Posterior pole view · 2228x1652:
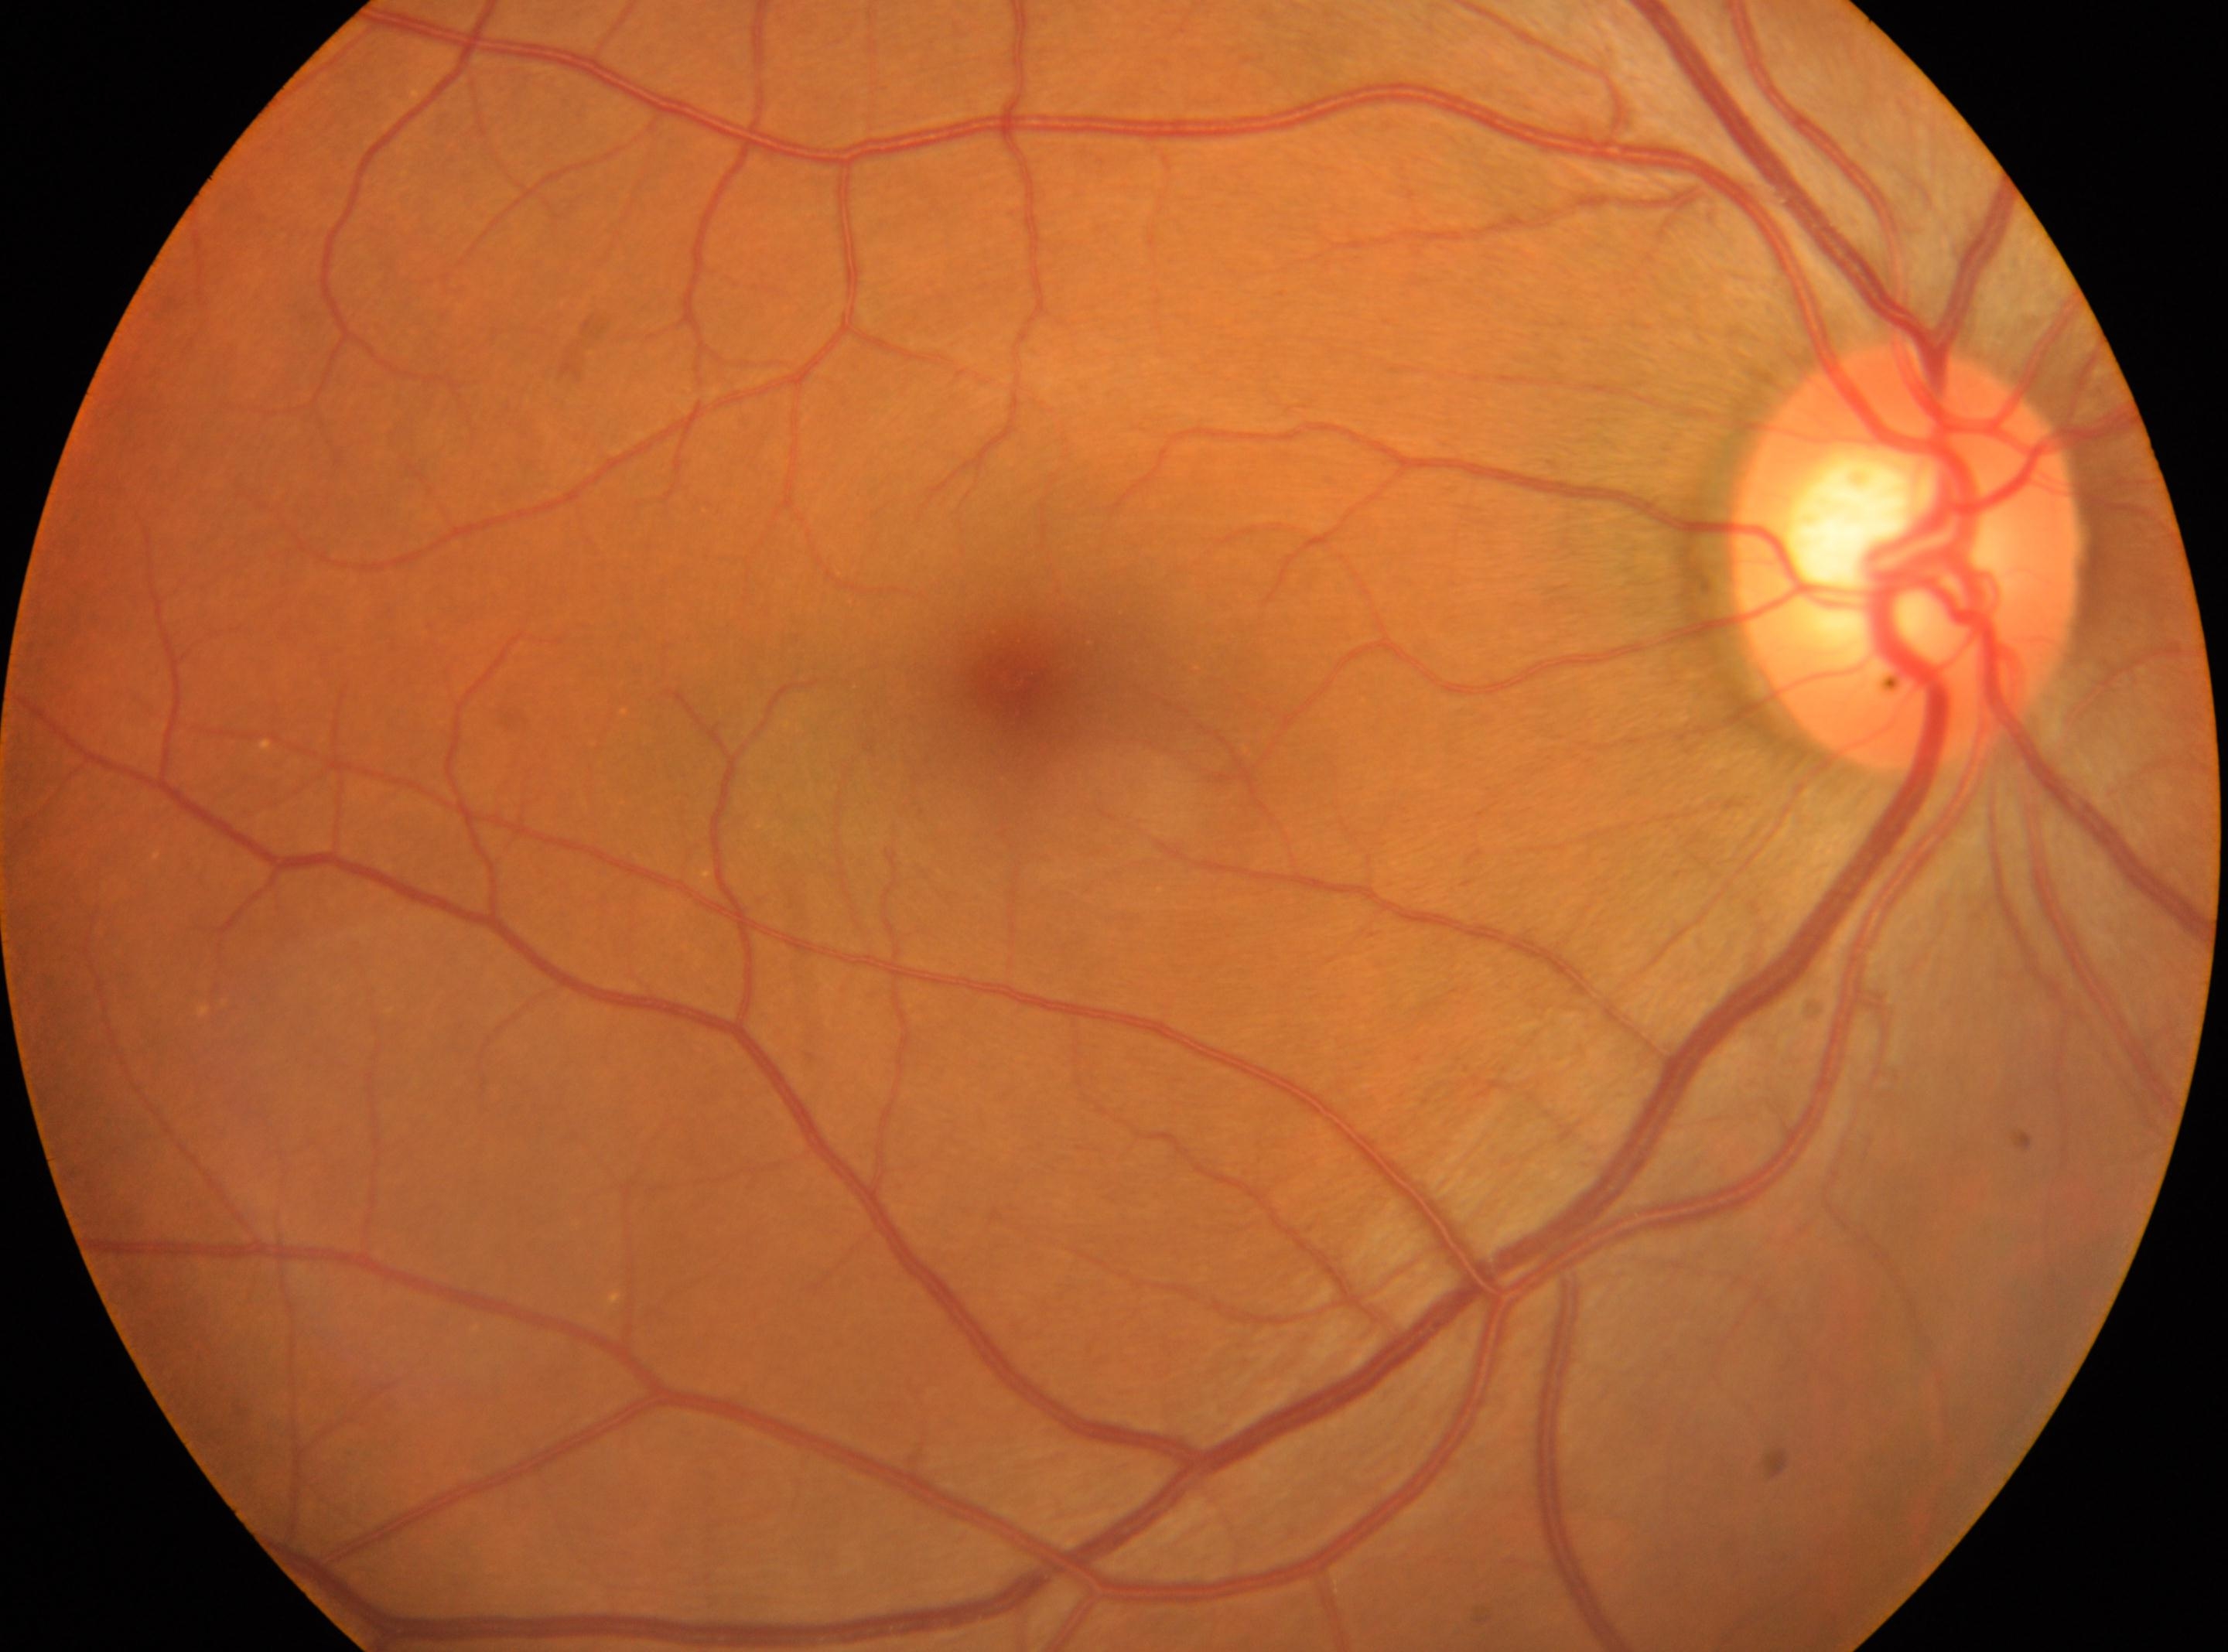

Diabetic retinopathy grade is 0. The fovea is at 1010px, 682px. No signs of diabetic retinopathy. The image shows the OD. Optic disc: 1906px, 557px.